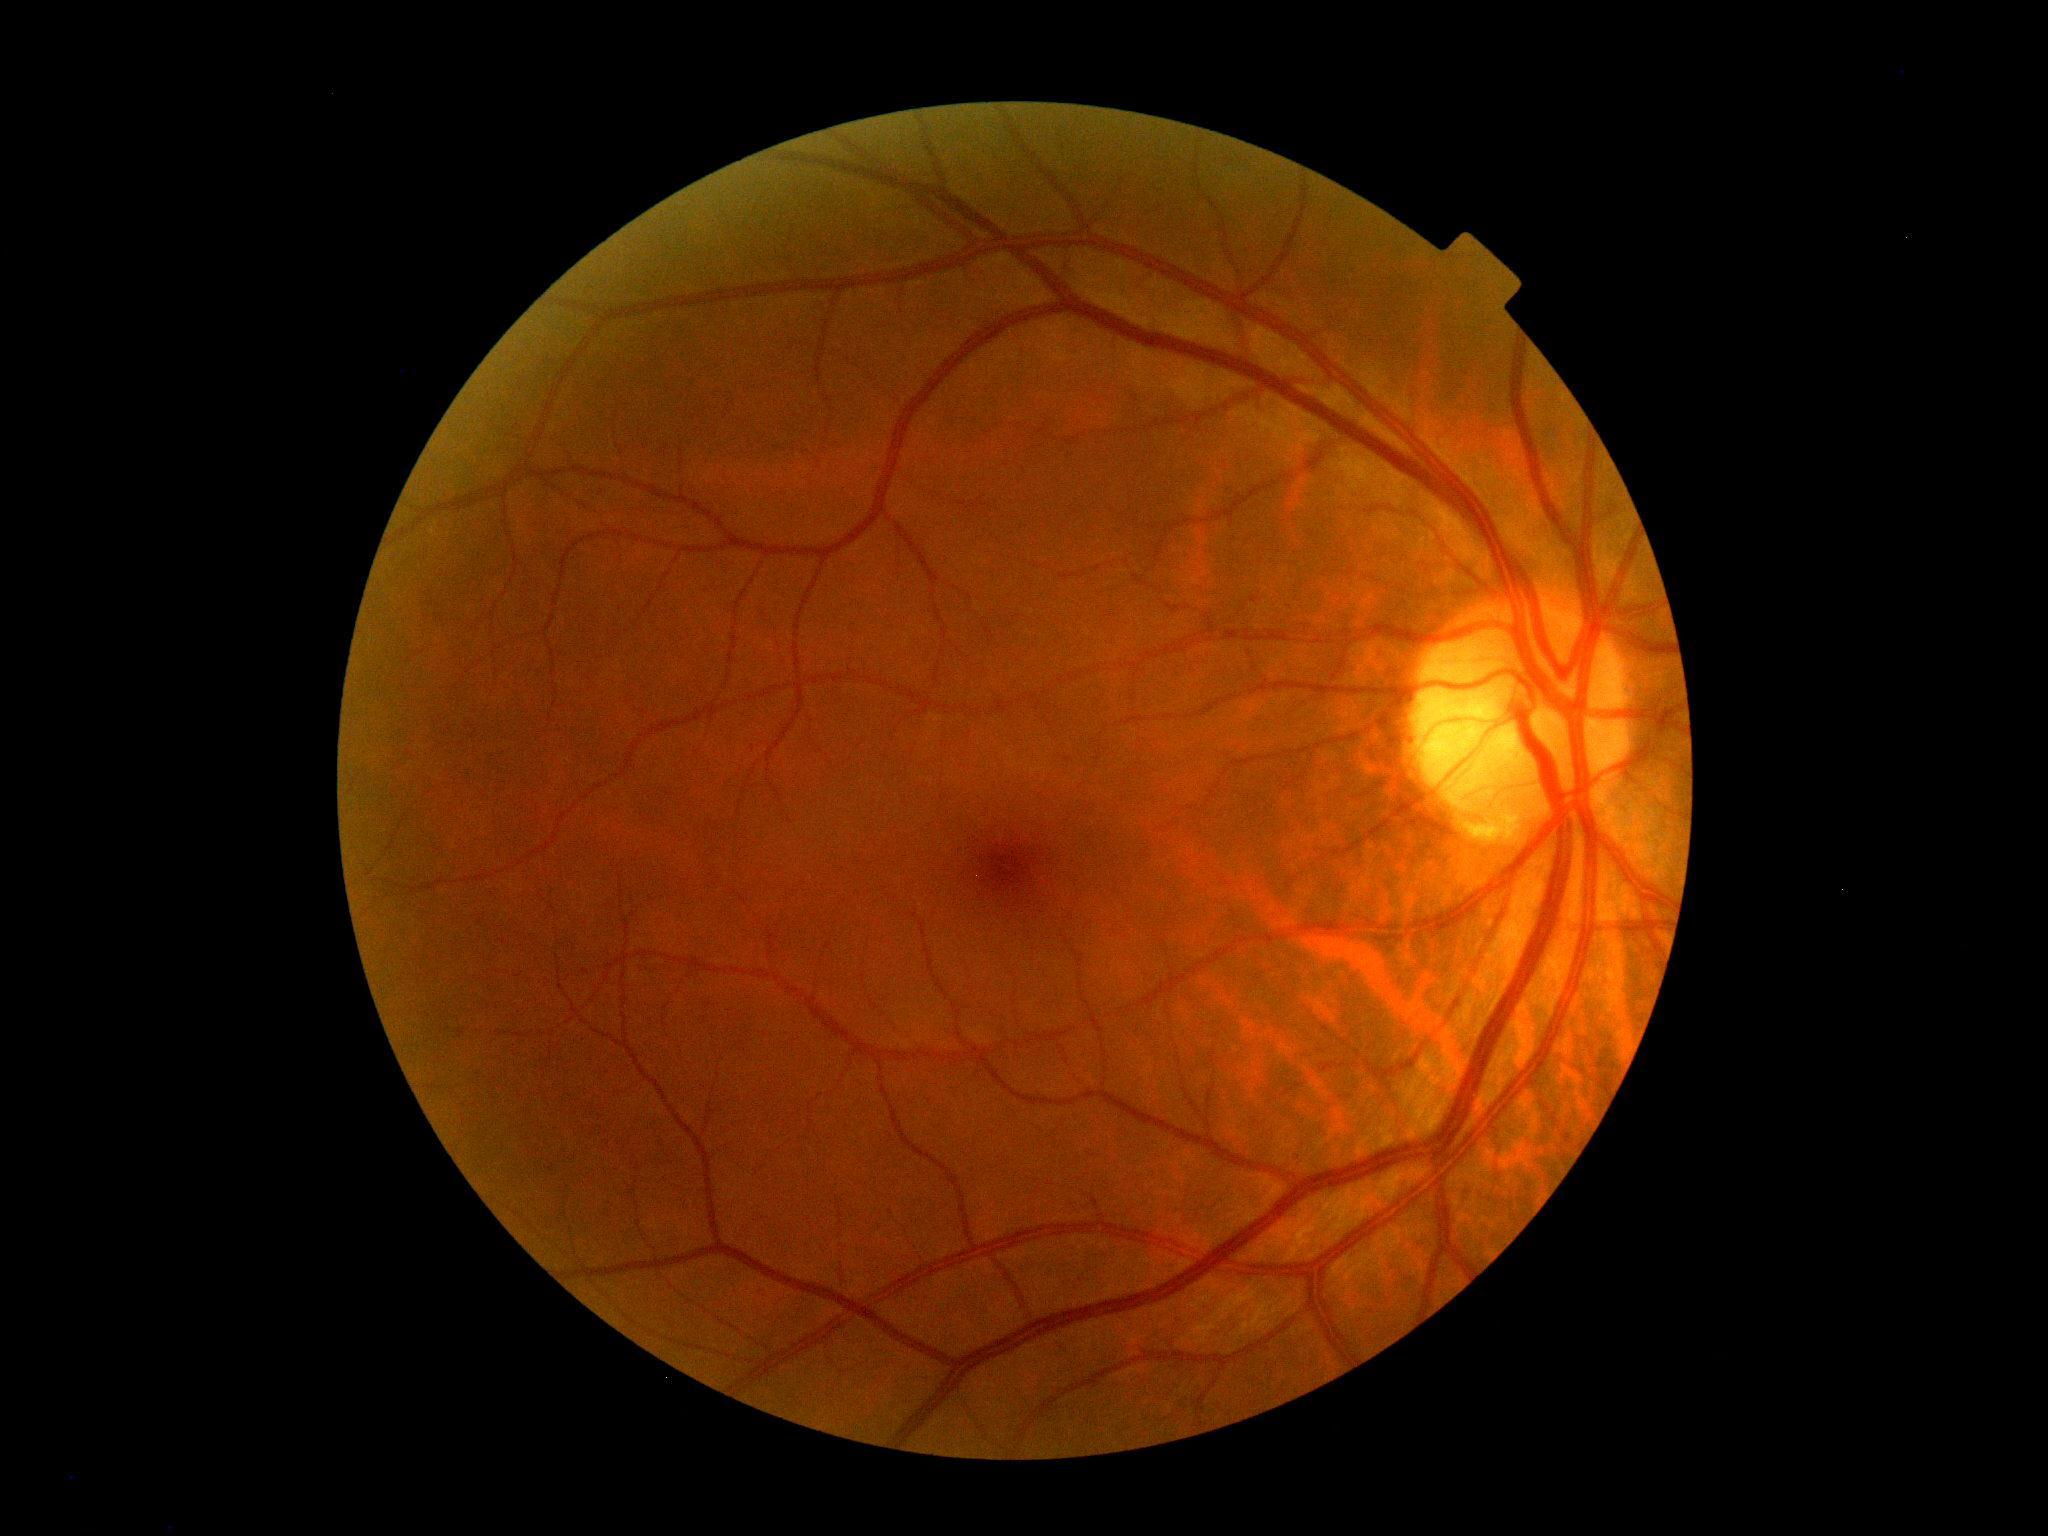 Diabetic retinopathy grade is 0 (no apparent retinopathy).